Diabetic retinopathy graded by the modified Davis classification — 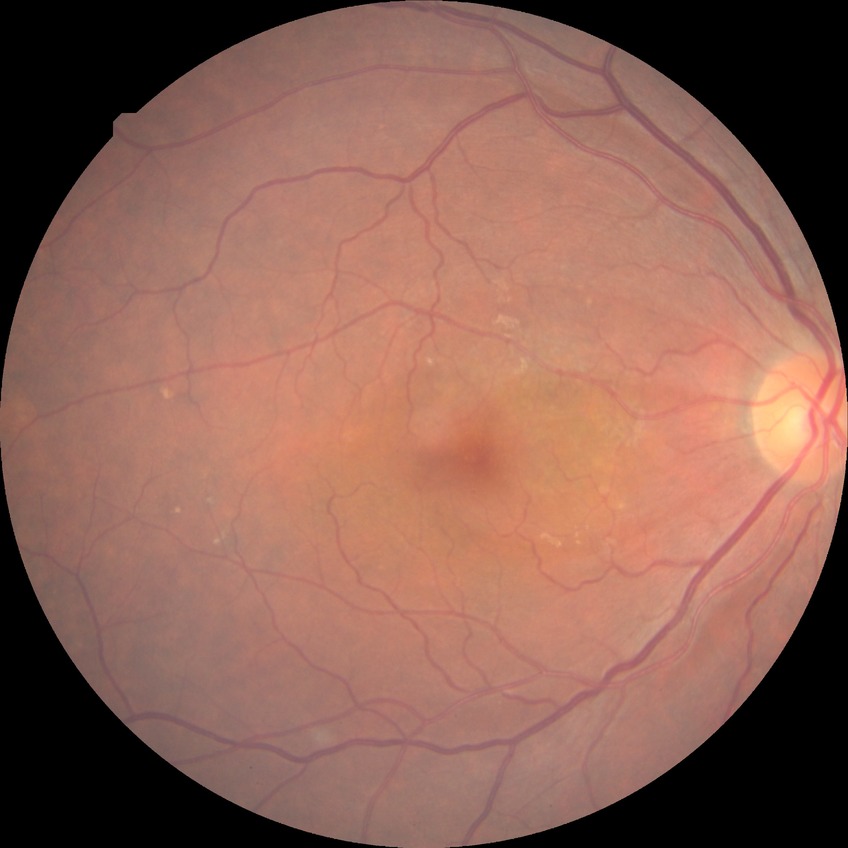
diabetic retinopathy (DR): NDR (no diabetic retinopathy)